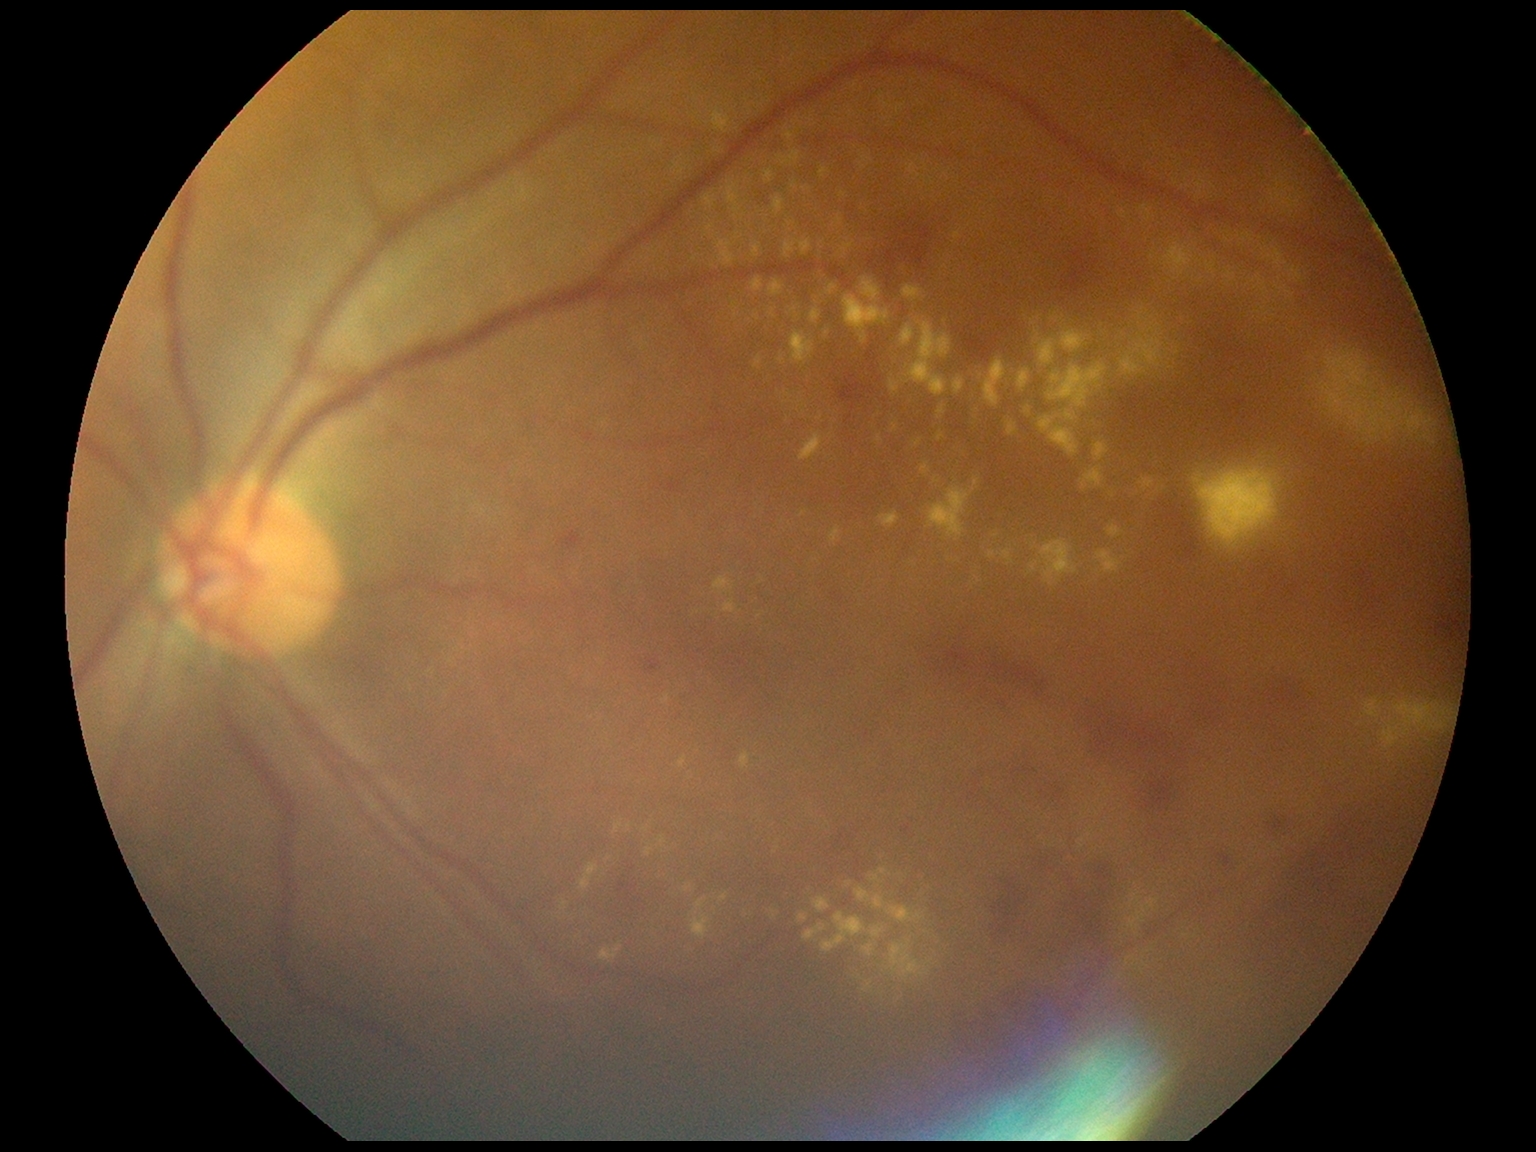 dr_grade: grade 2 (moderate NPDR)